240 by 240 pixels:
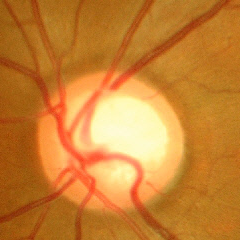
Glaucoma assessment: severe glaucomatous damage.